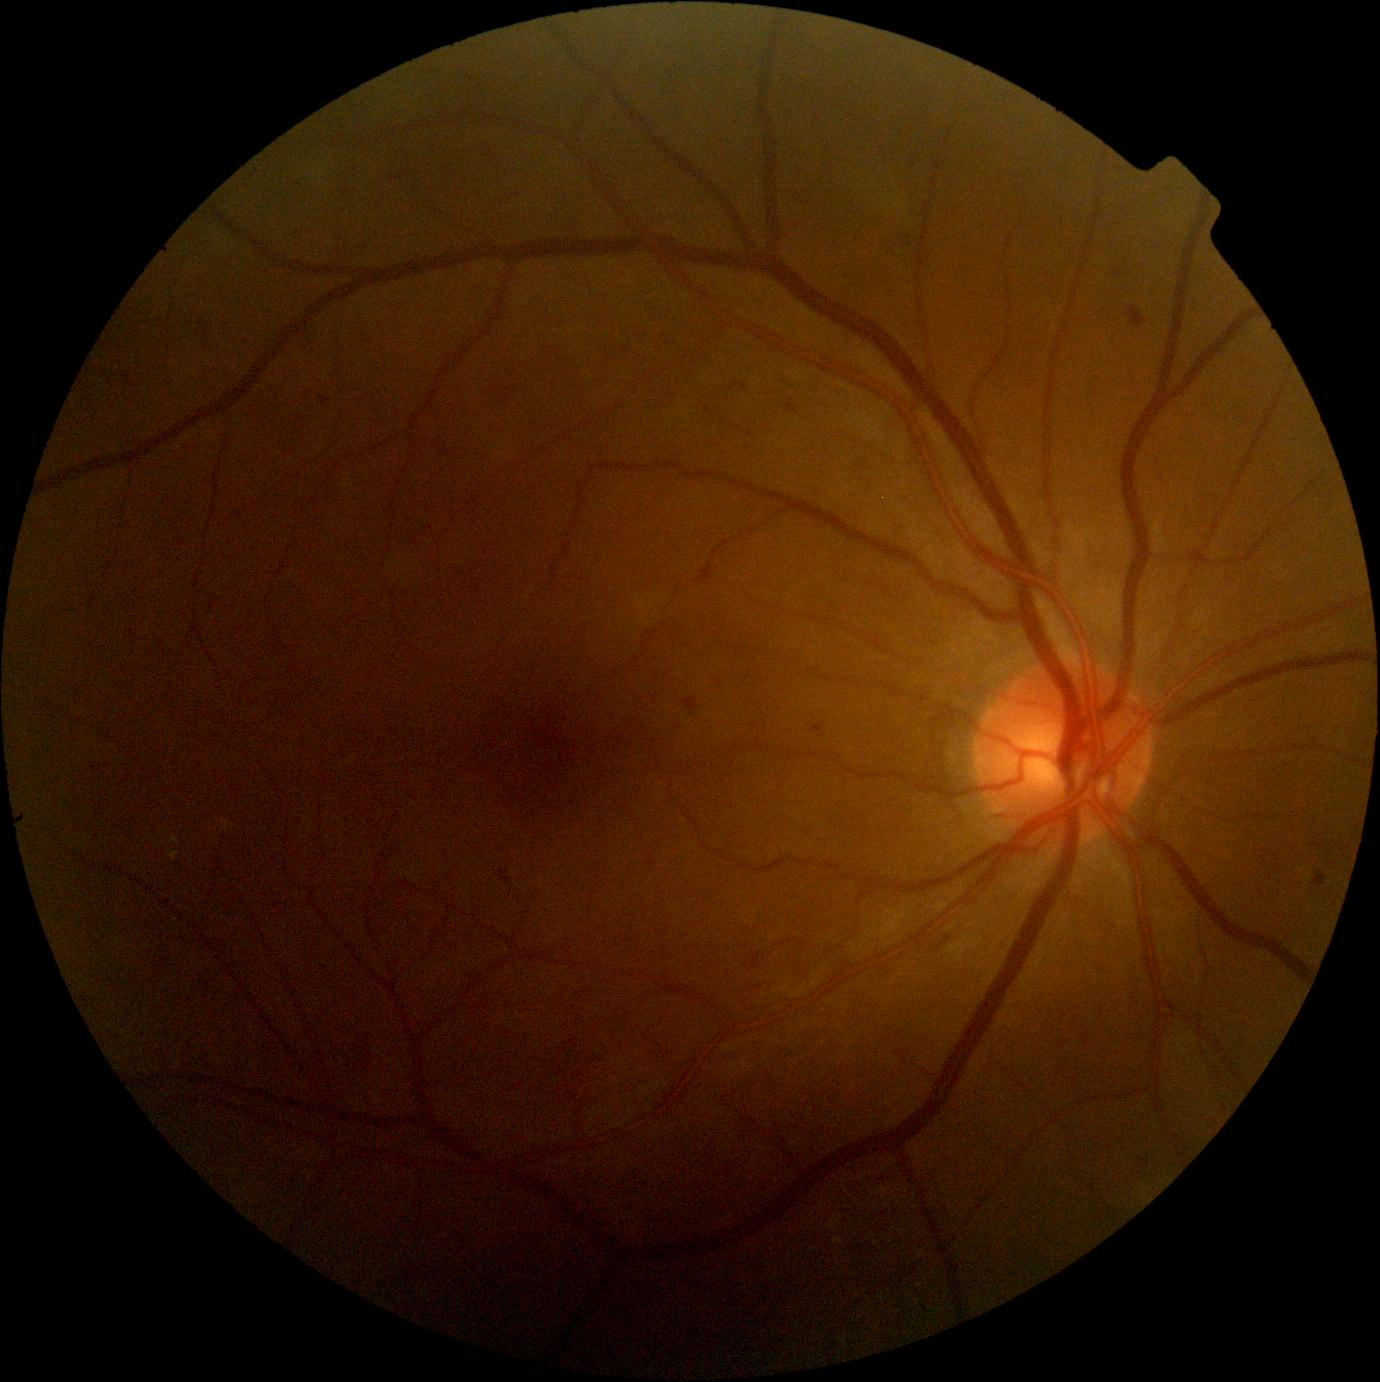

• DR grade — 2